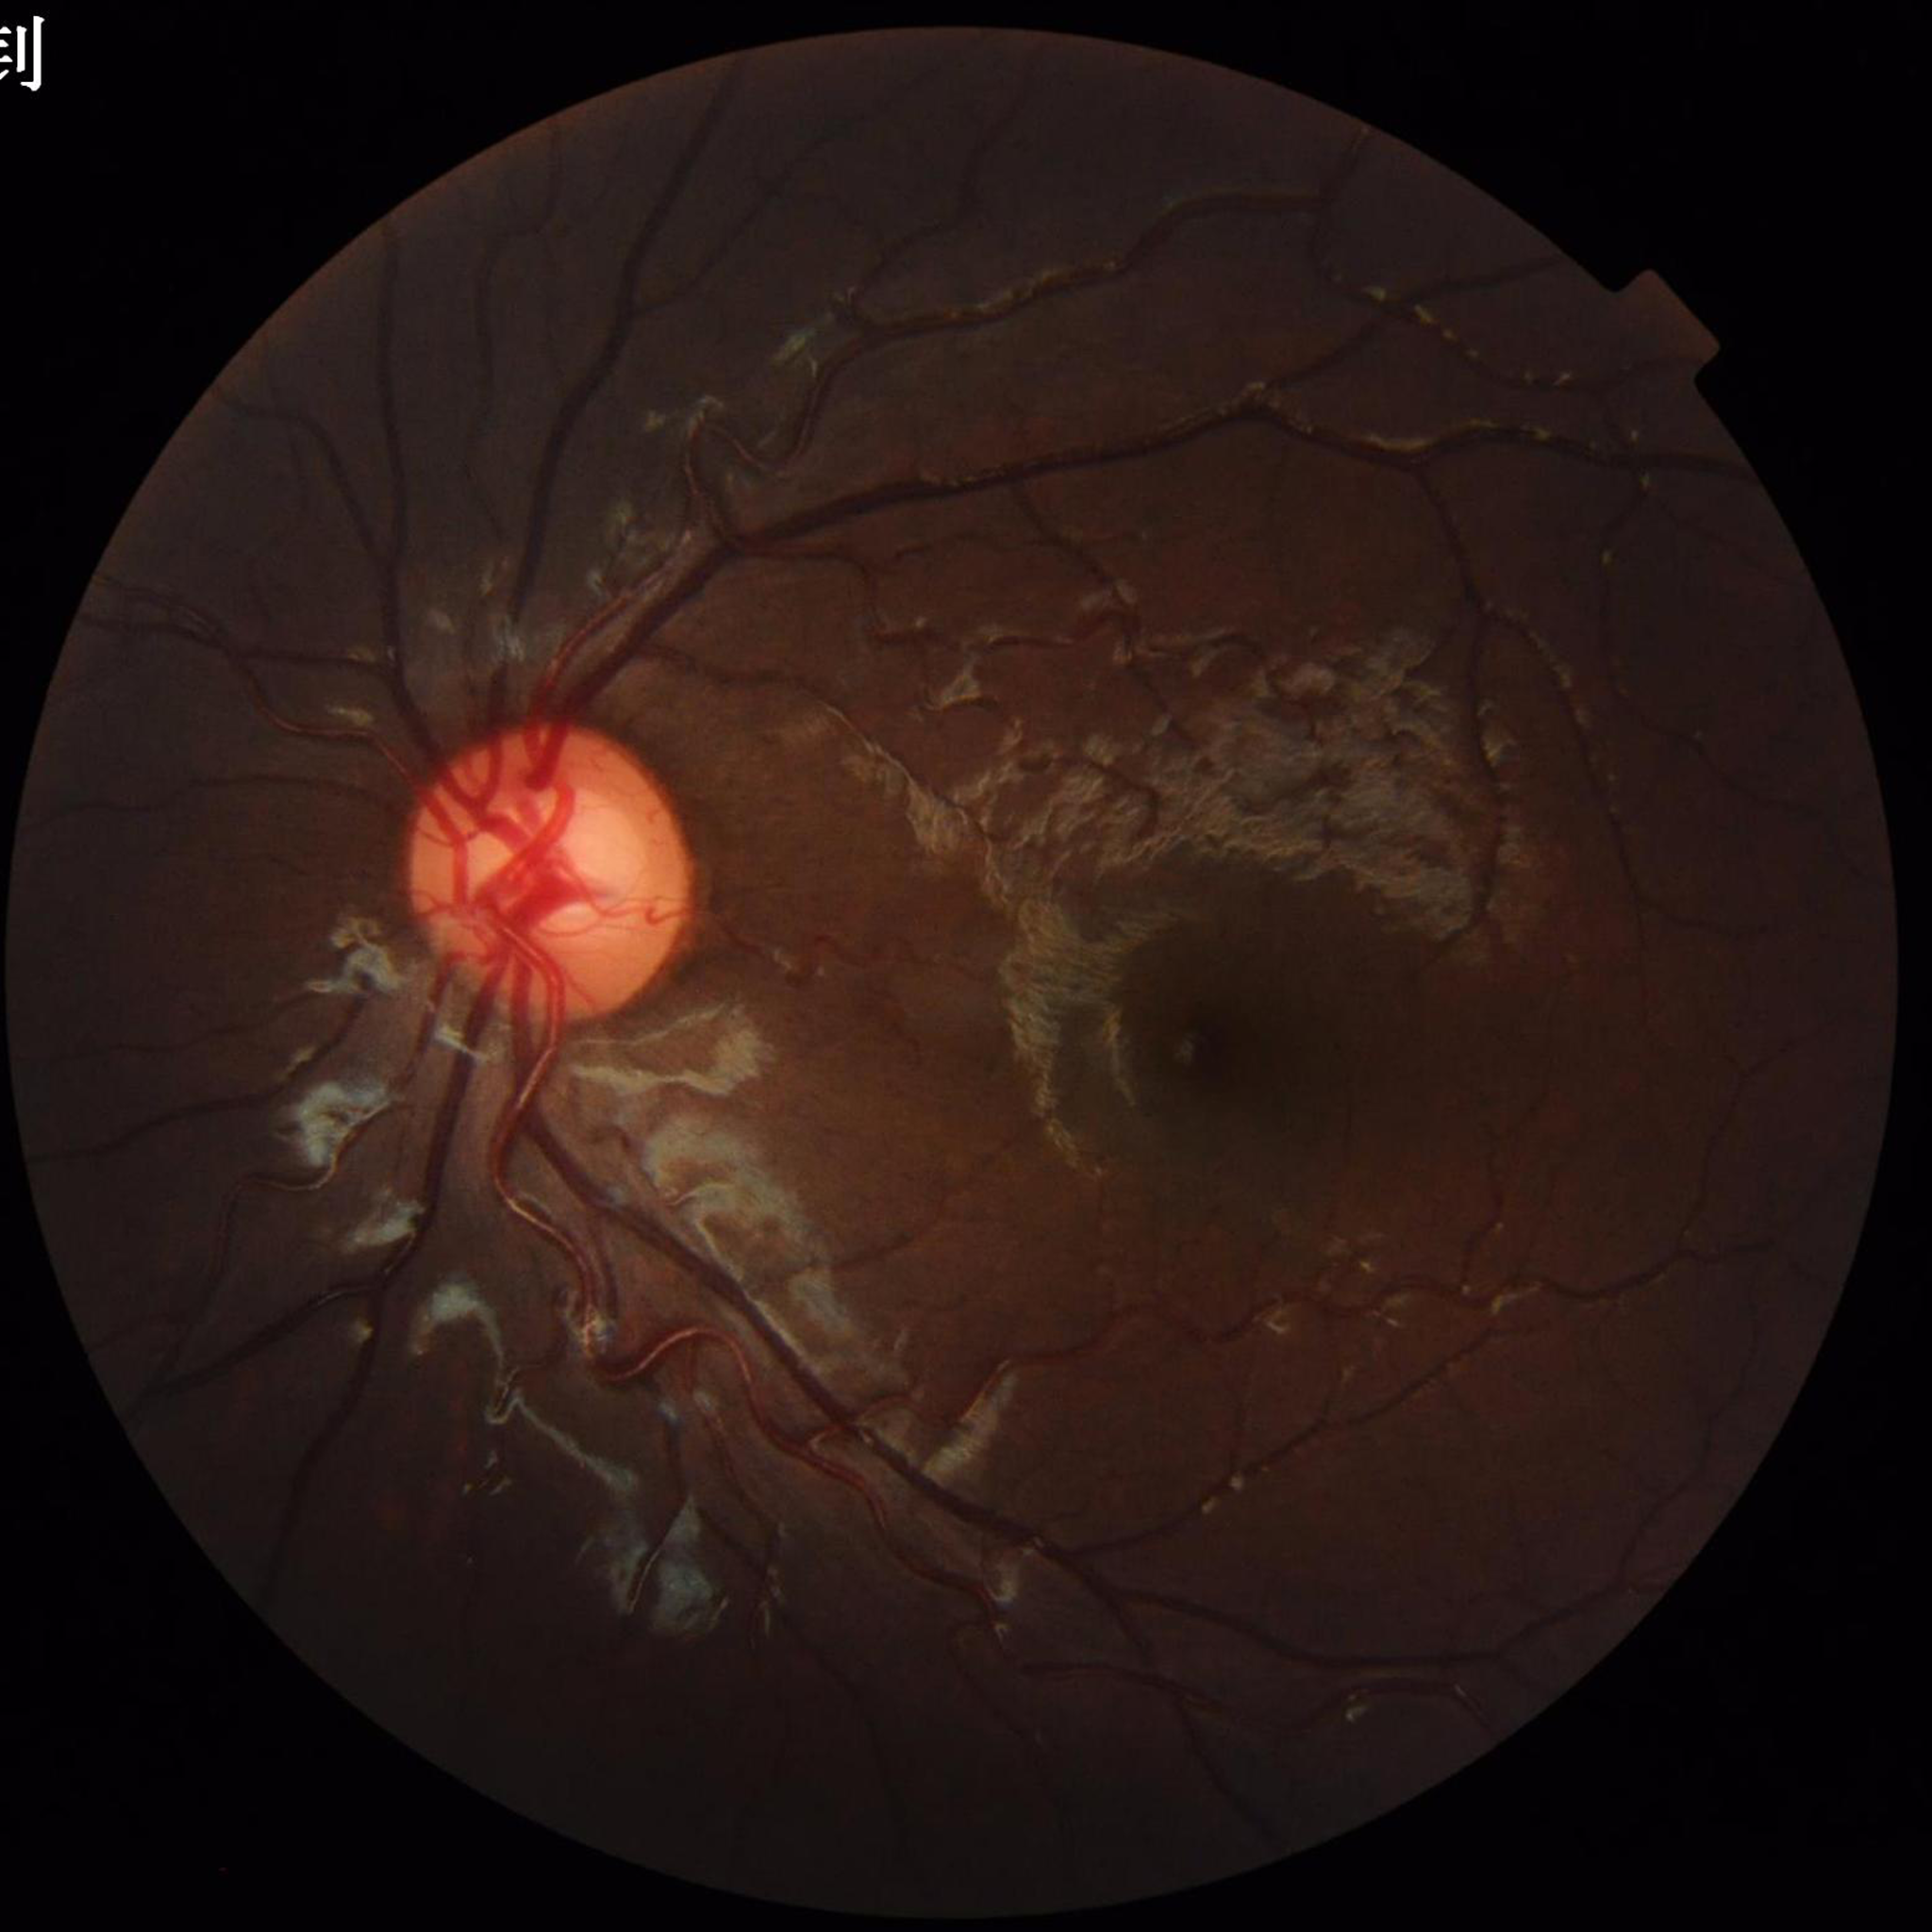   image_quality: no blur, contrast adequate, illumination/color distortion present
  diagnosis: no AMD, diabetic retinopathy, or glaucoma